Nonmydriatic, 848 by 848 pixels, 45-degree field of view, posterior pole photograph, NIDEK AFC-230 fundus camera — 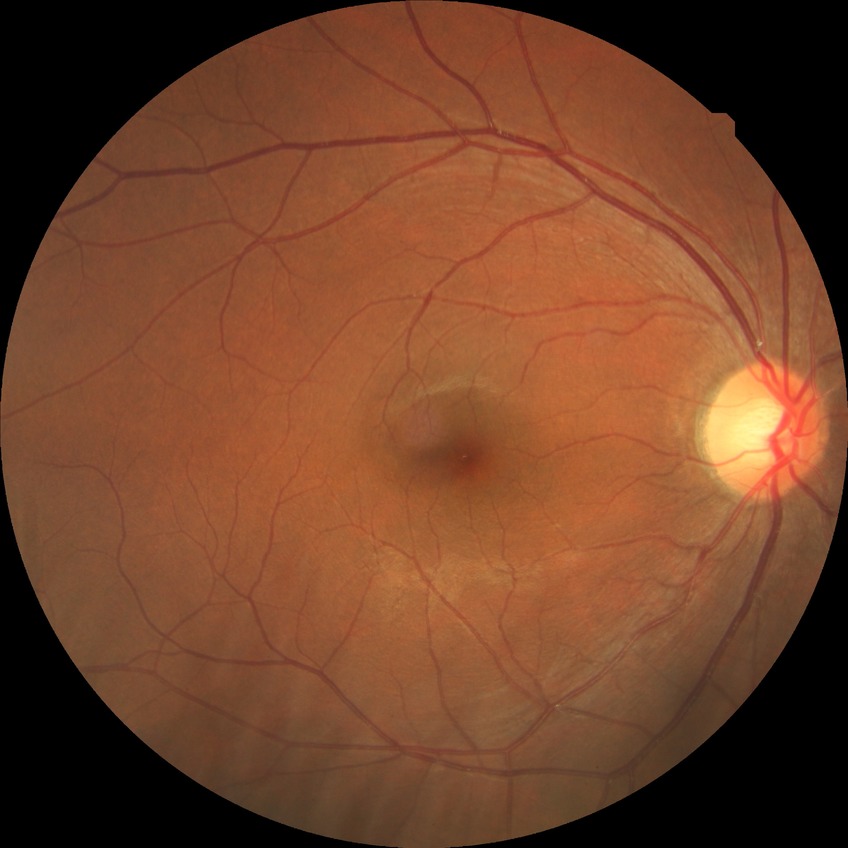

diabetic retinopathy (DR): no diabetic retinopathy (NDR).